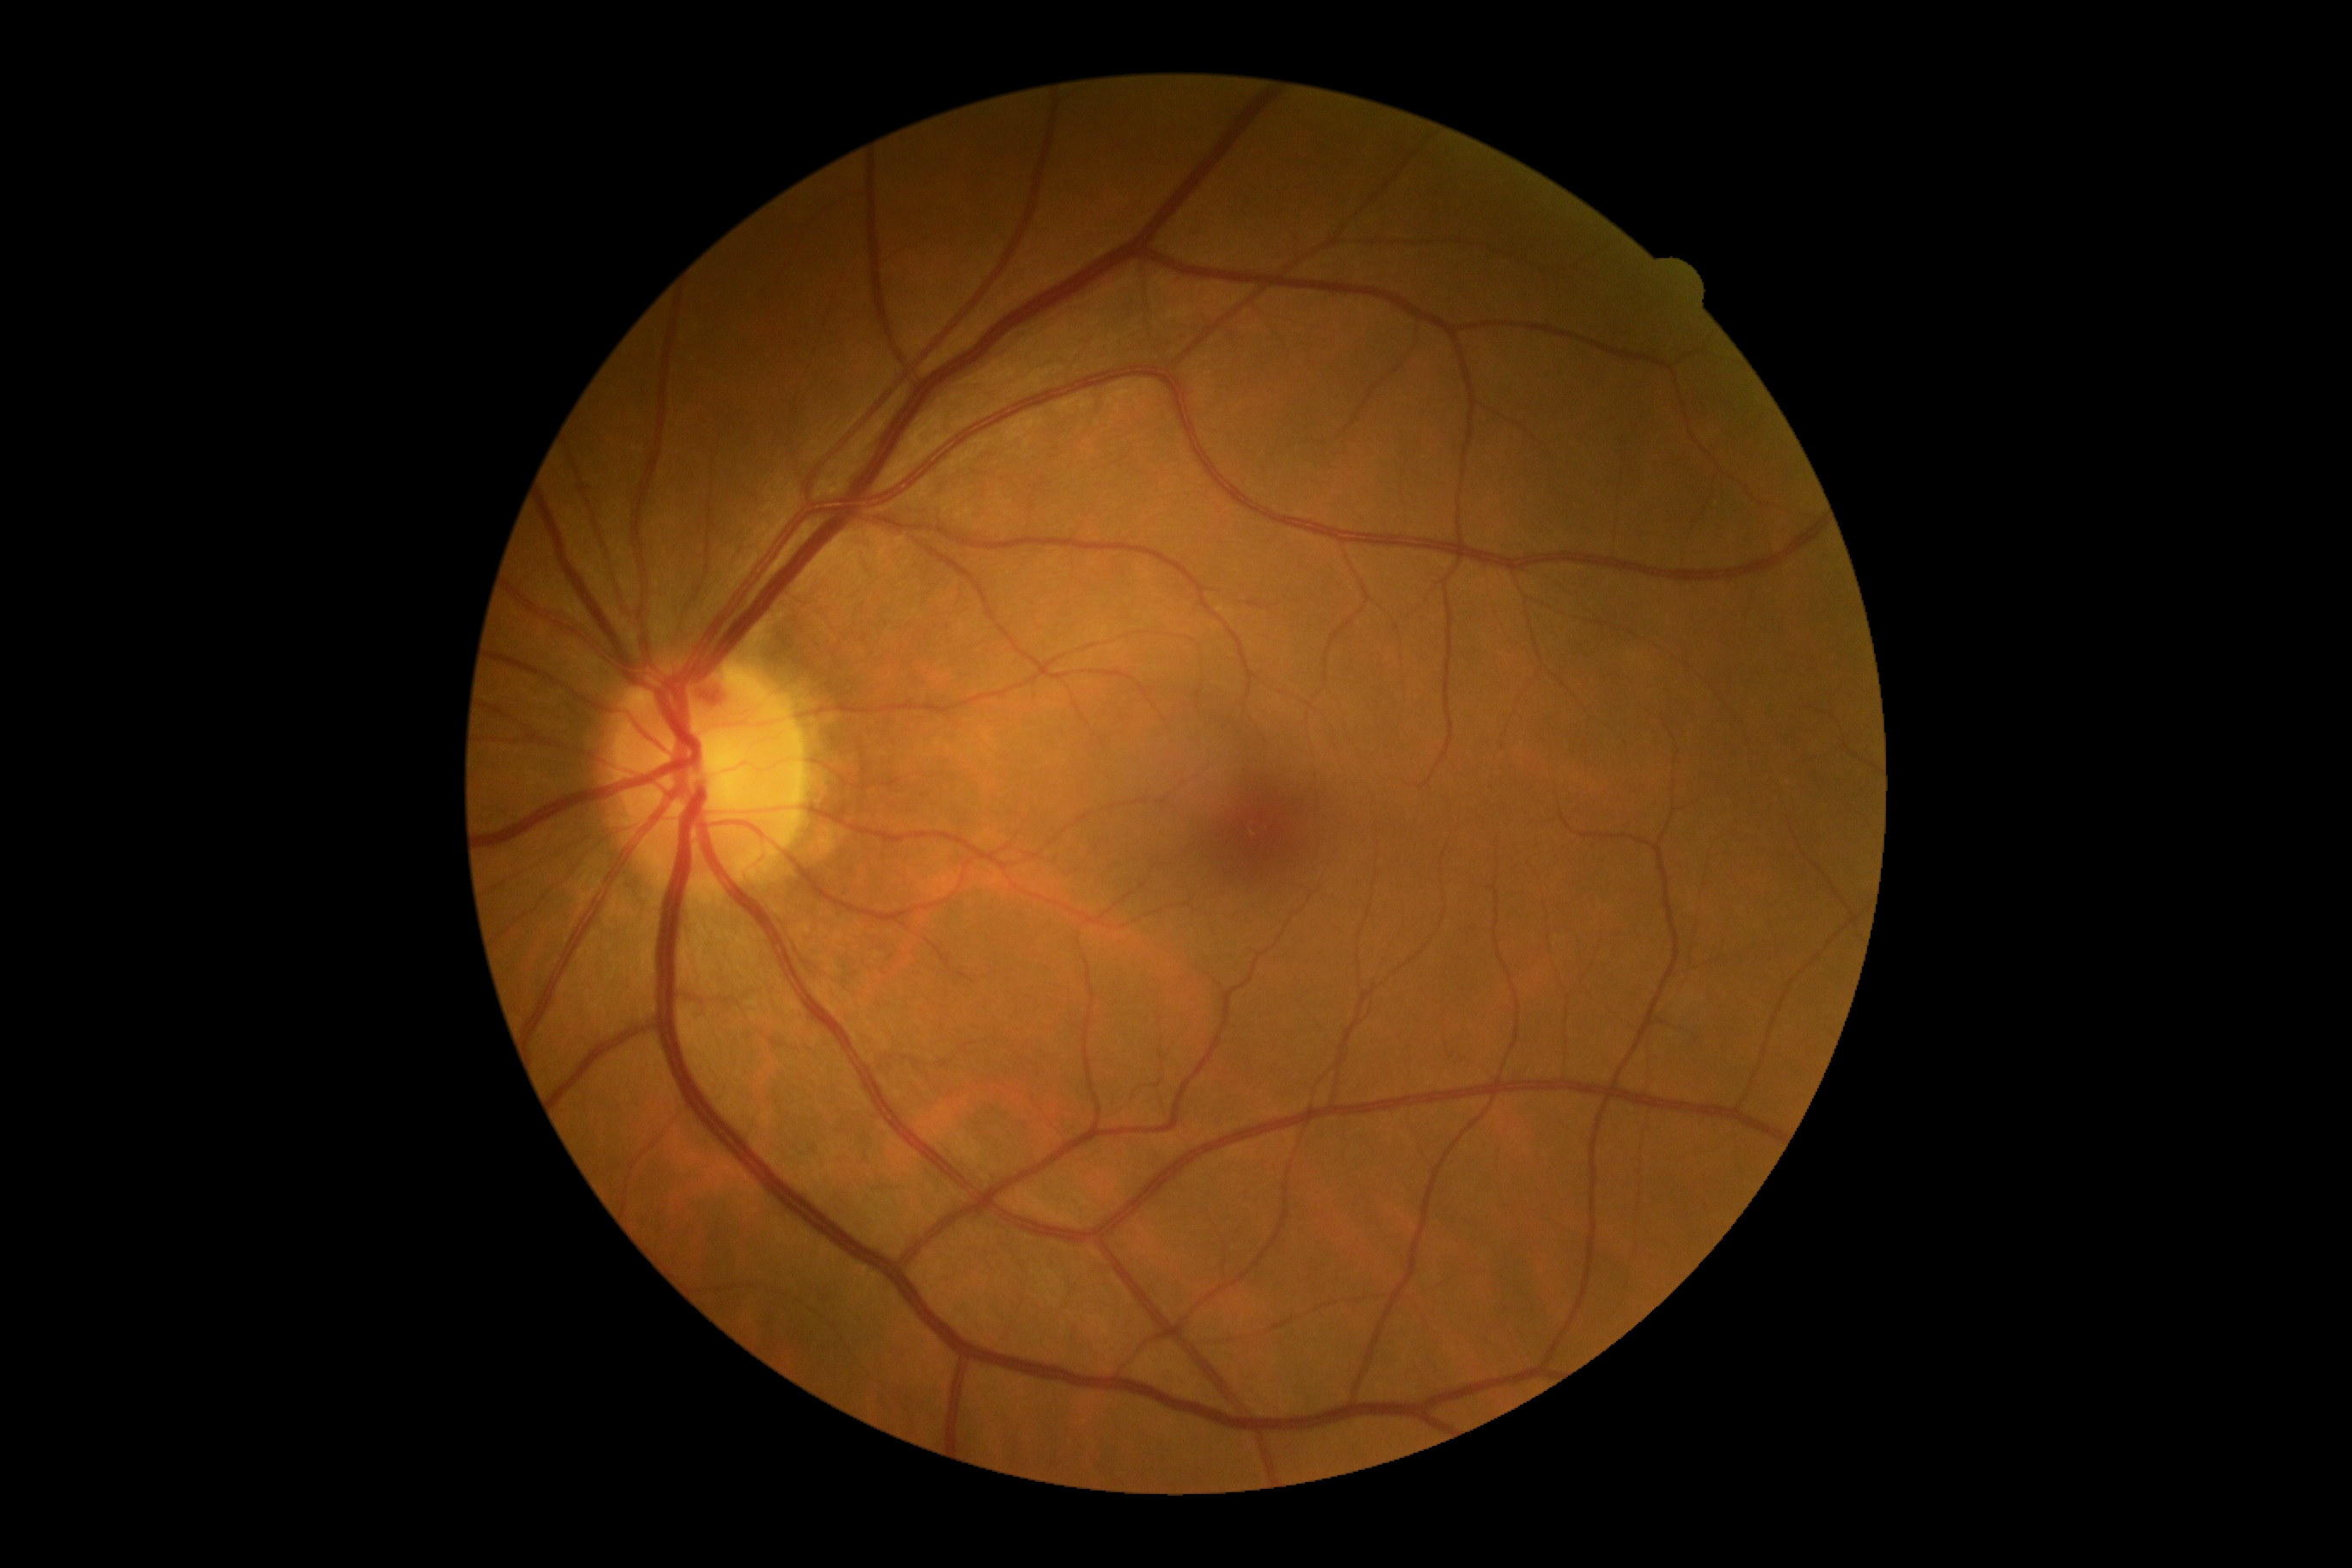 DR grade is no apparent diabetic retinopathy (0).